CFP, 45° FOV, 2352x1568px
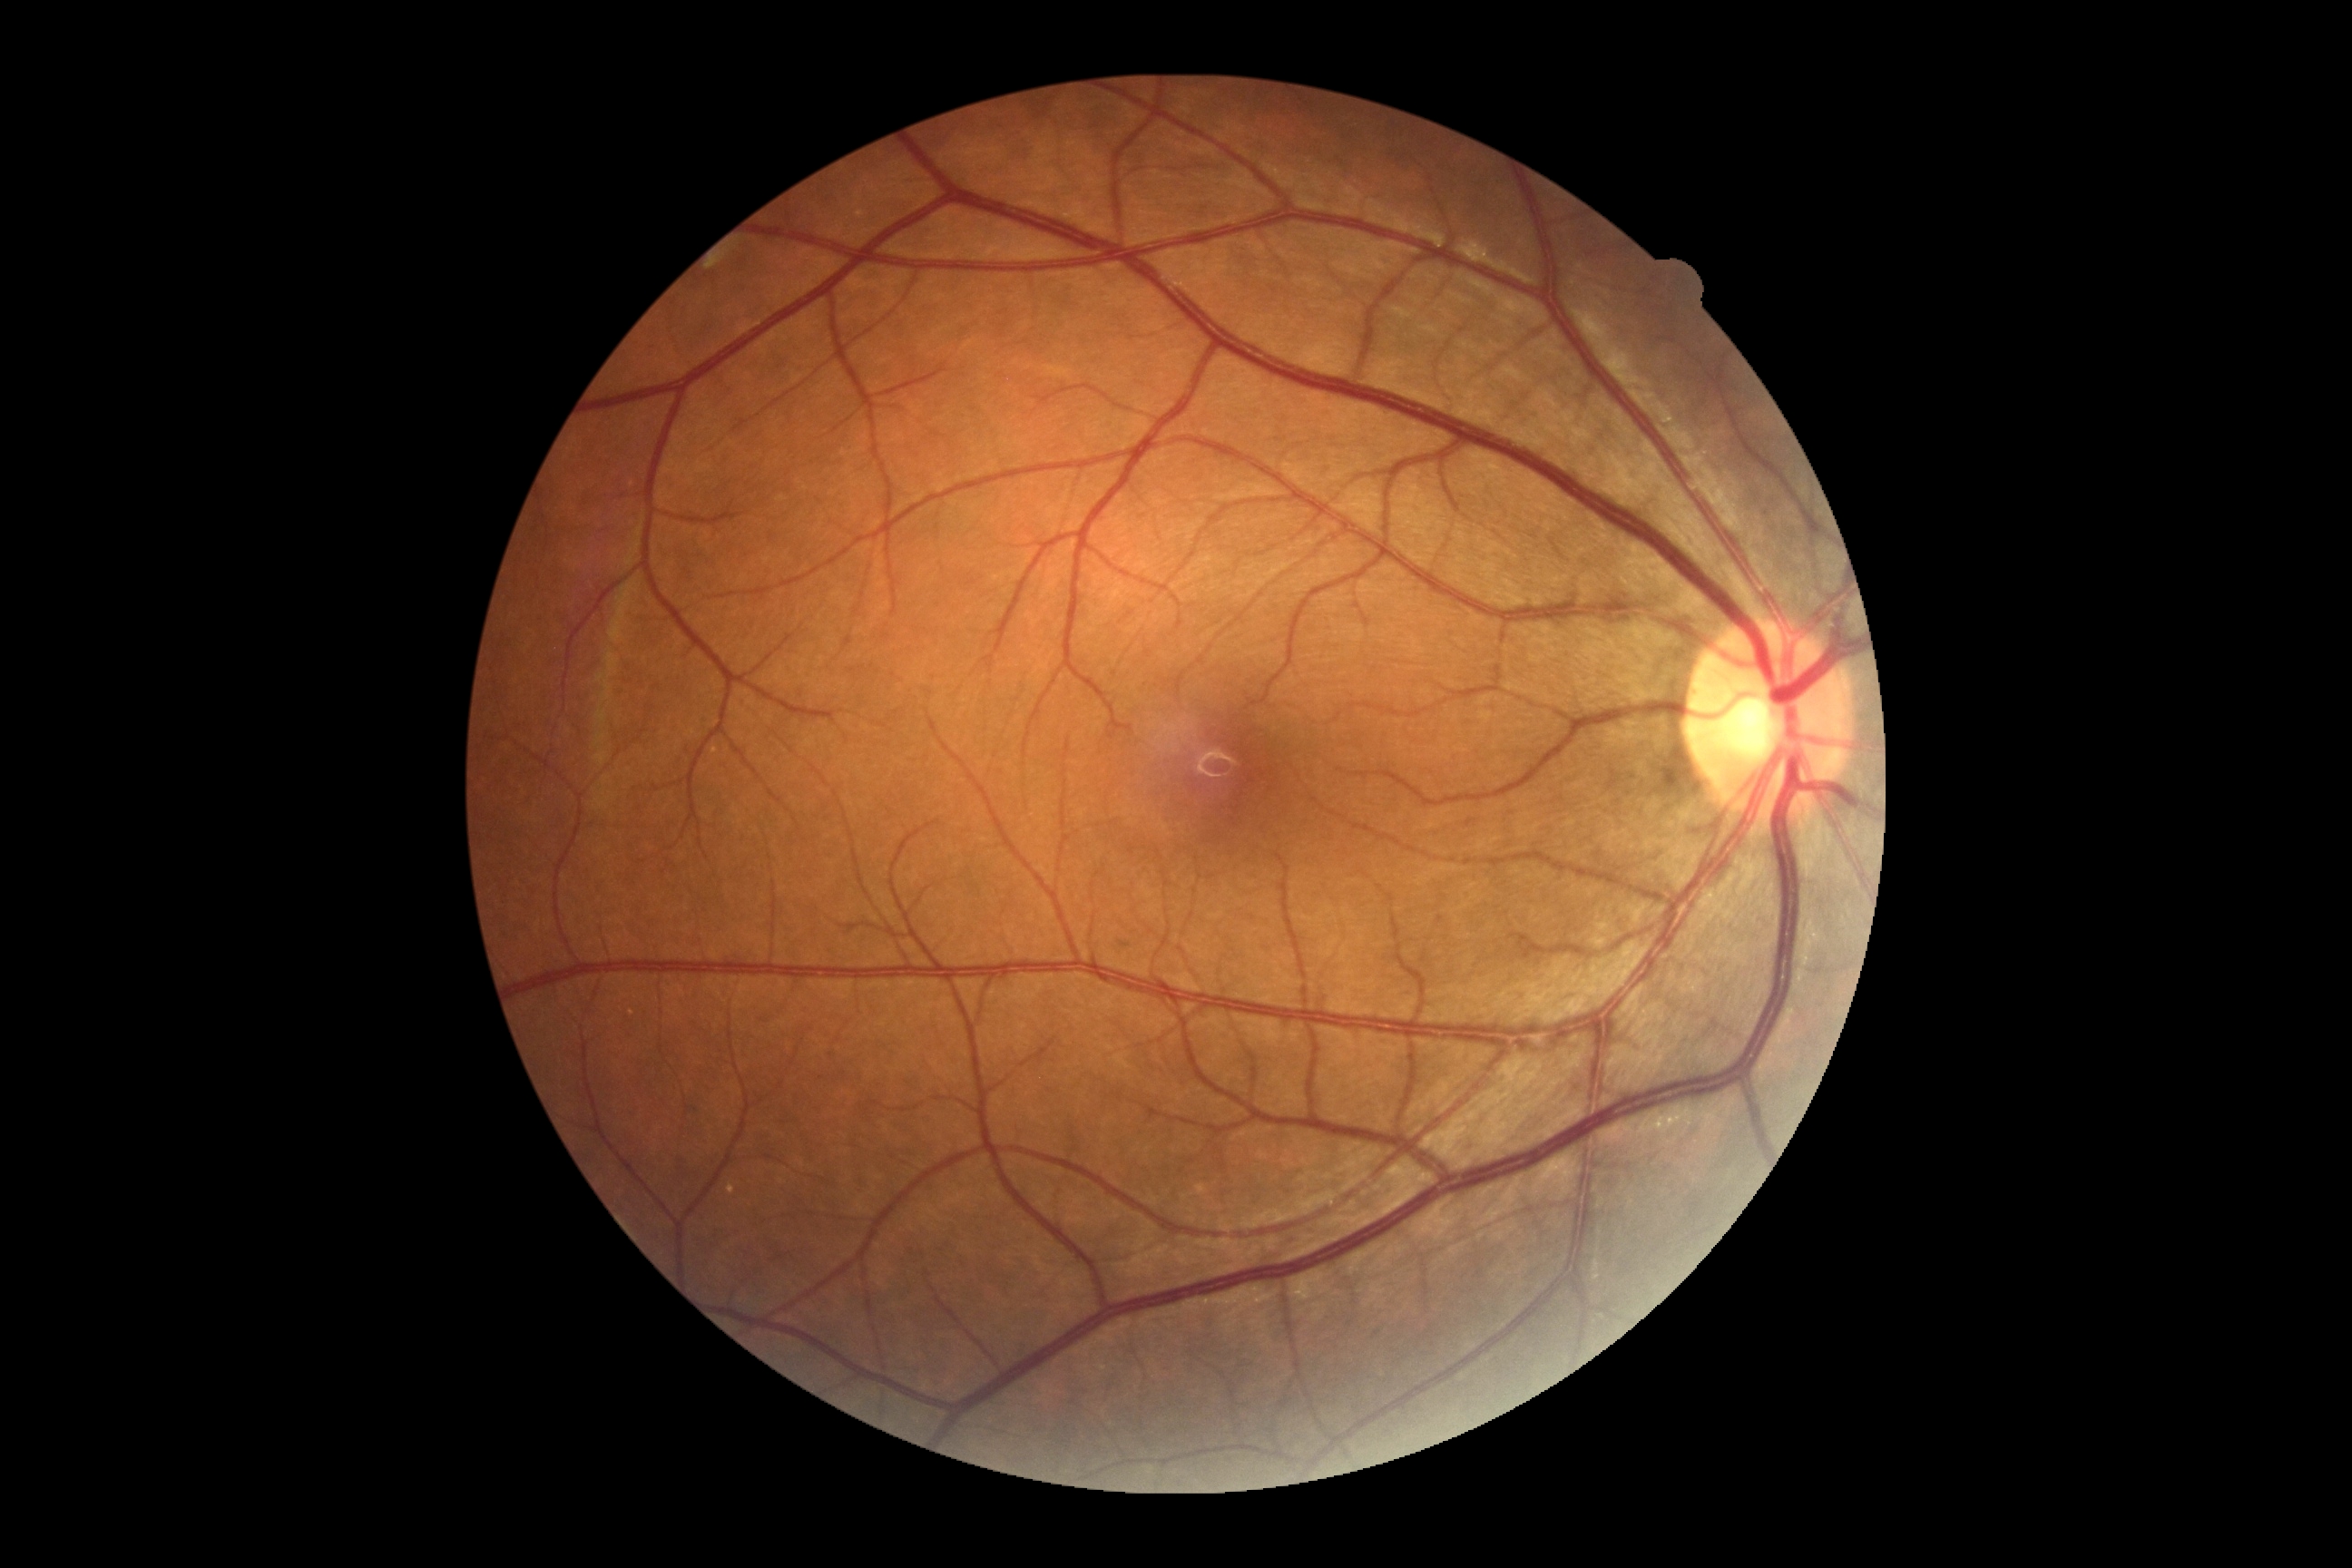
* DR impression — negative for DR
* DR grade — 0 (no apparent retinopathy)